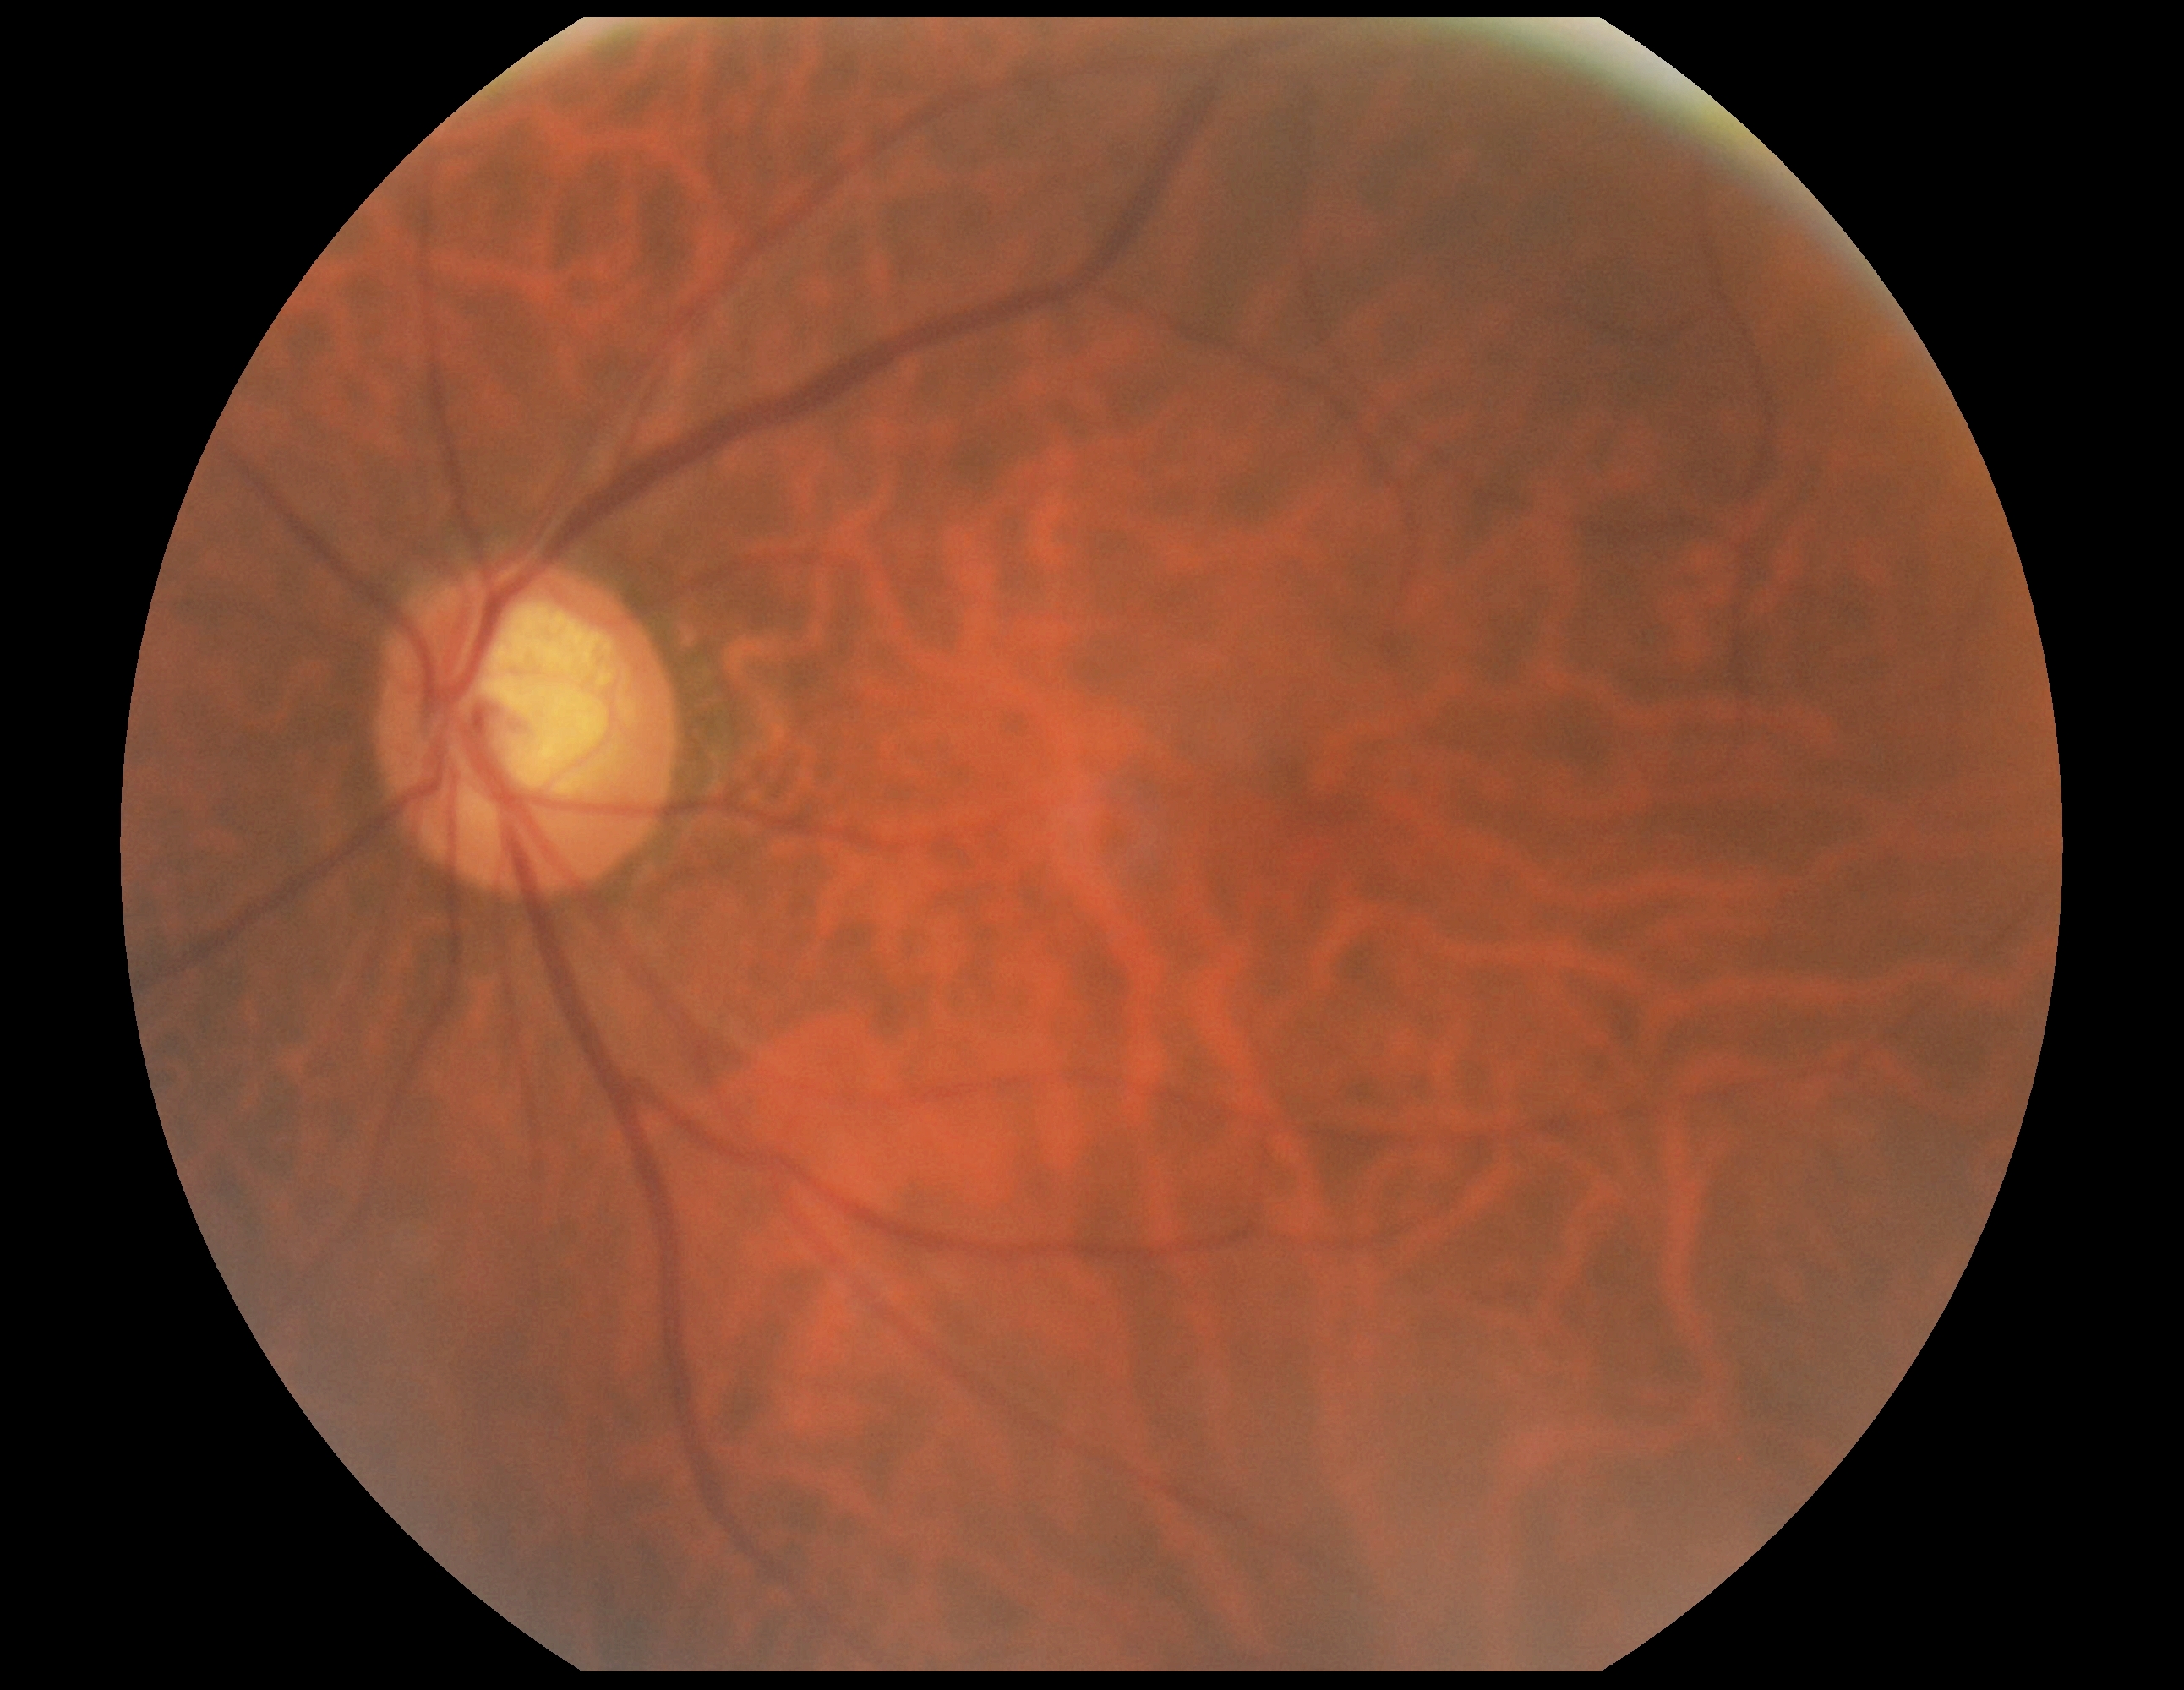 diabetic retinopathy (DR): grade 0 (no apparent retinopathy).